Without pupil dilation — 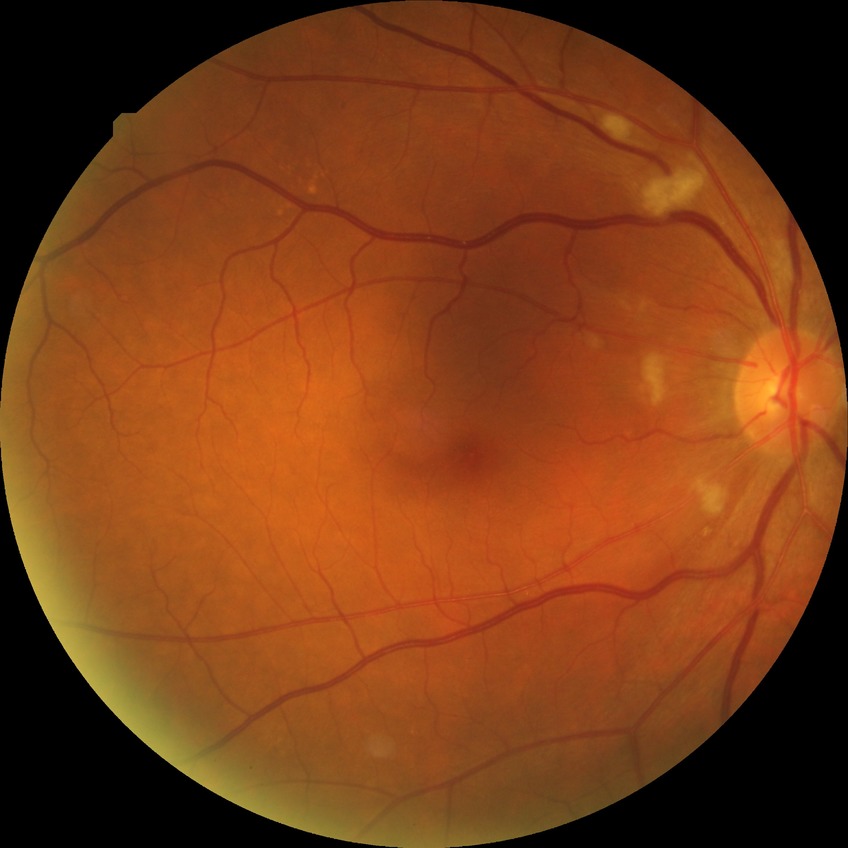

DR severity: NDR.